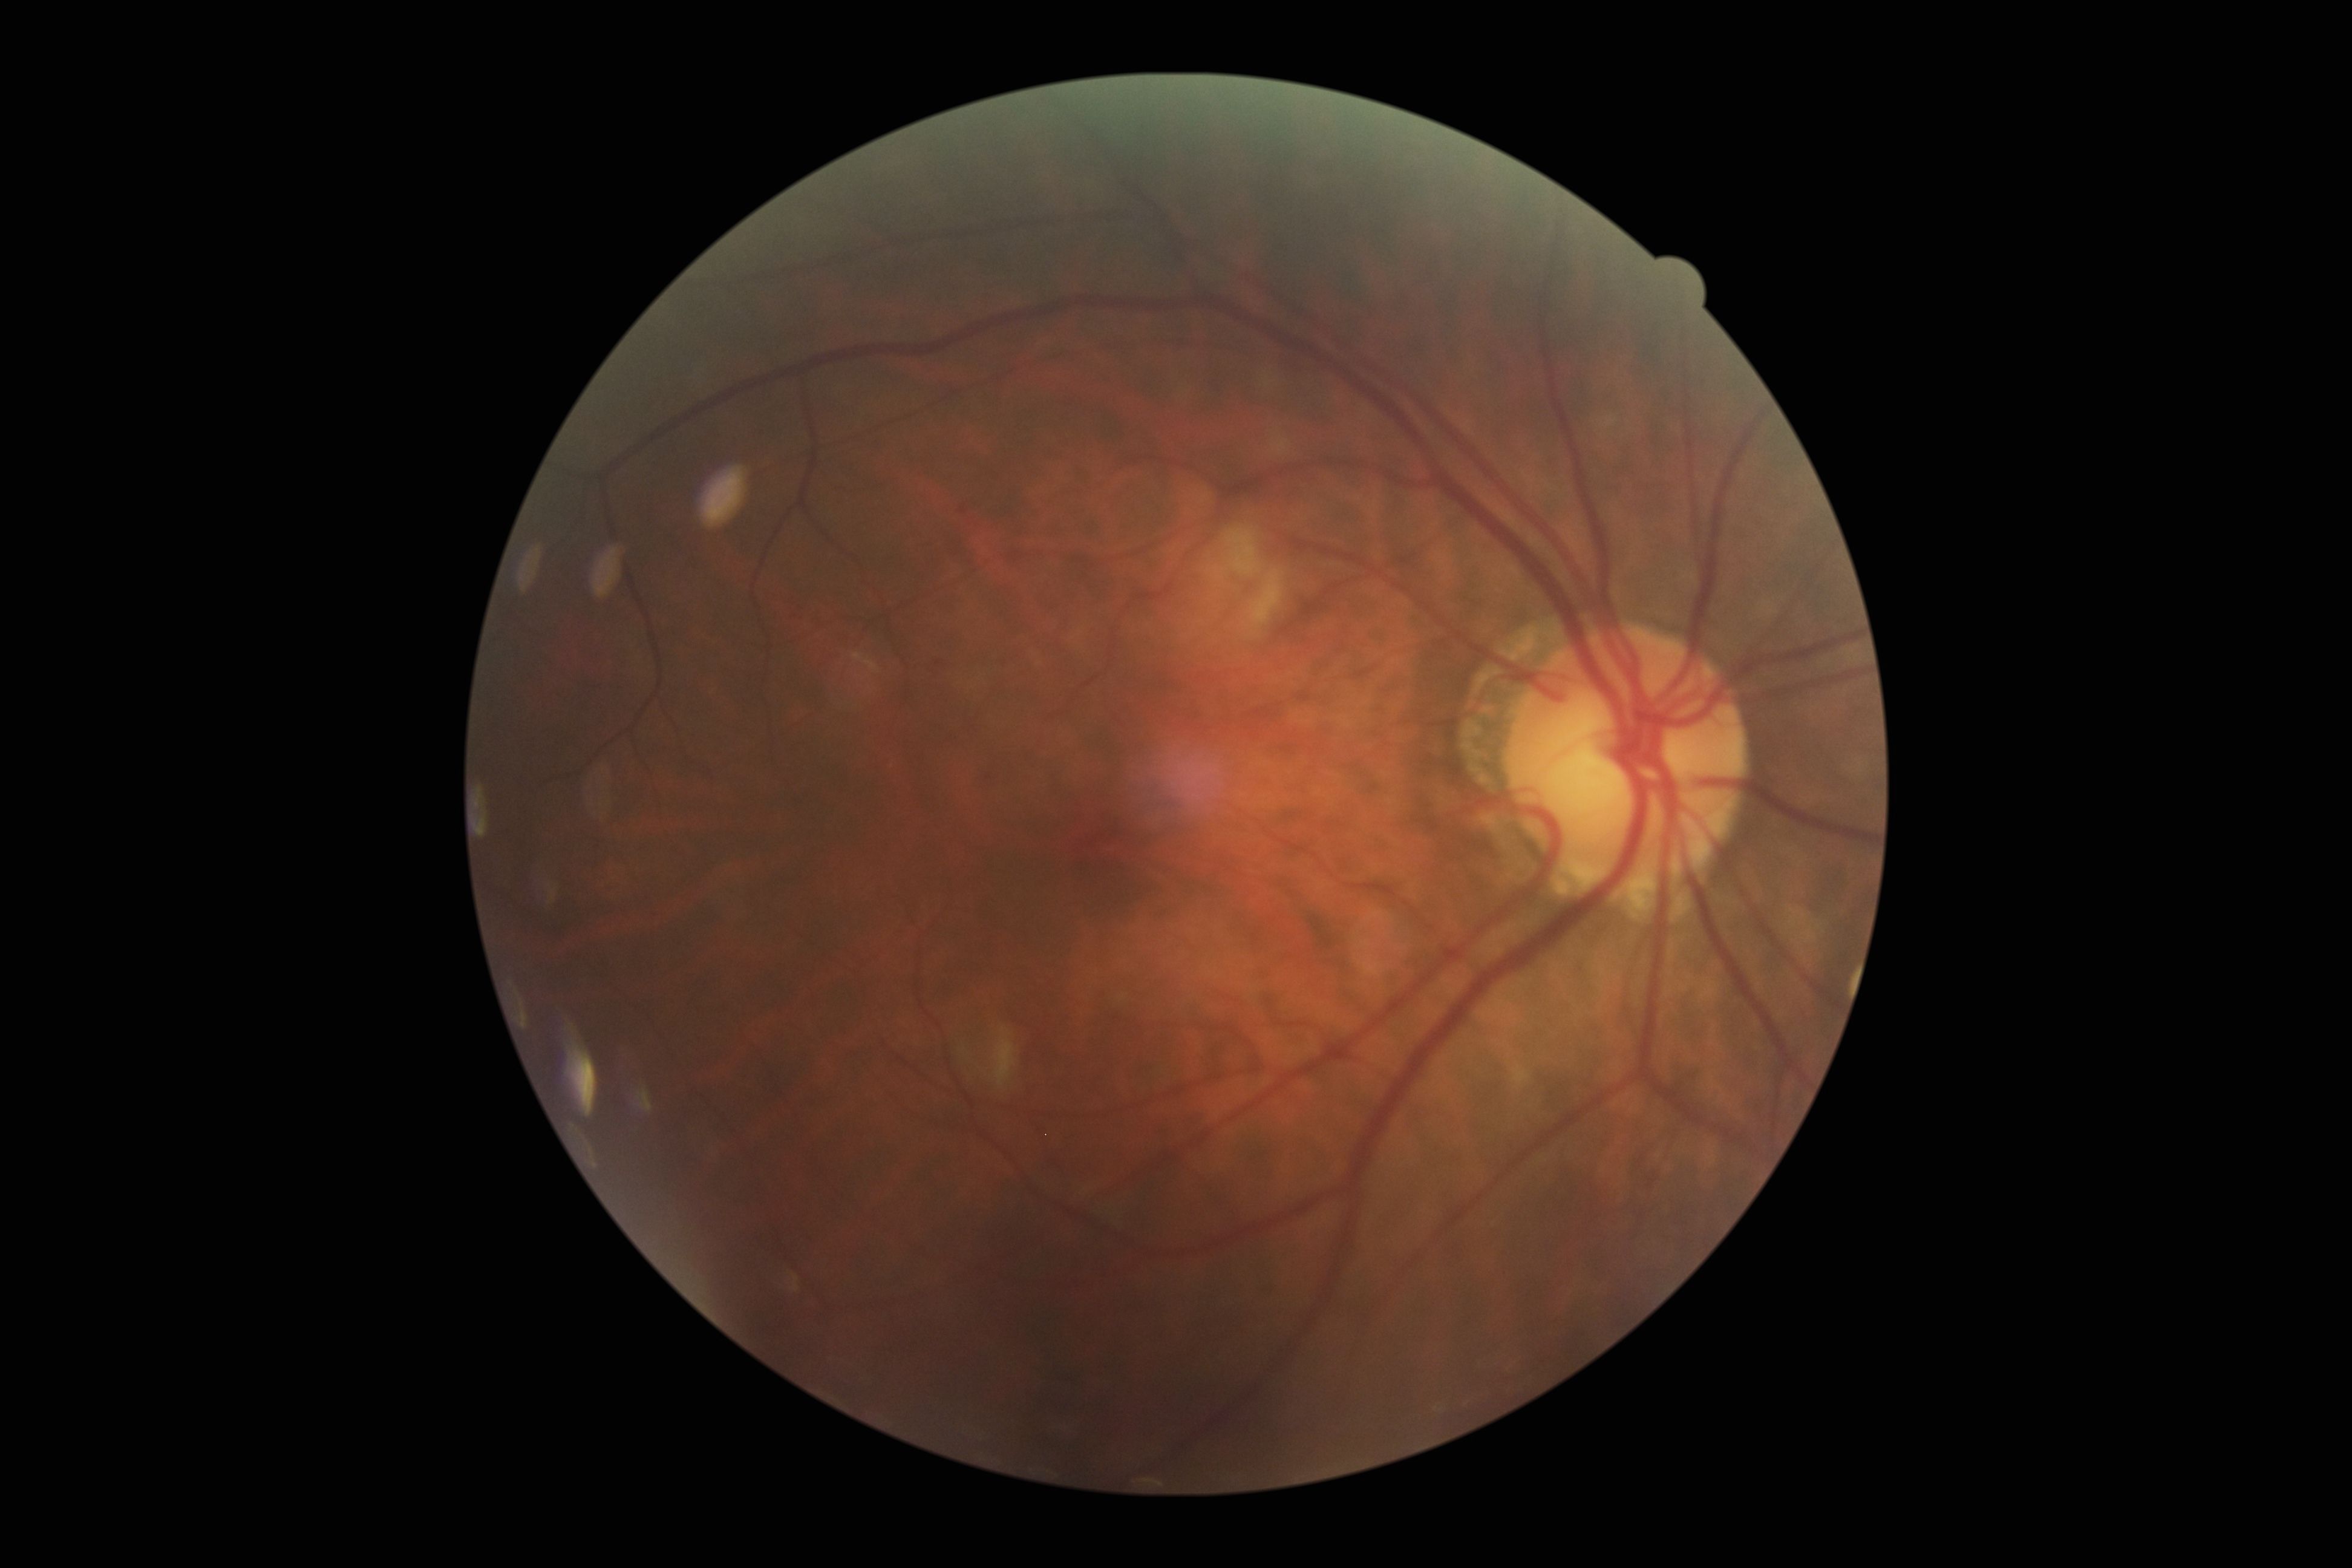

Diabetic retinopathy (DR) is moderate non-proliferative diabetic retinopathy (grade 2) — more than just microaneurysms but less than severe NPDR.